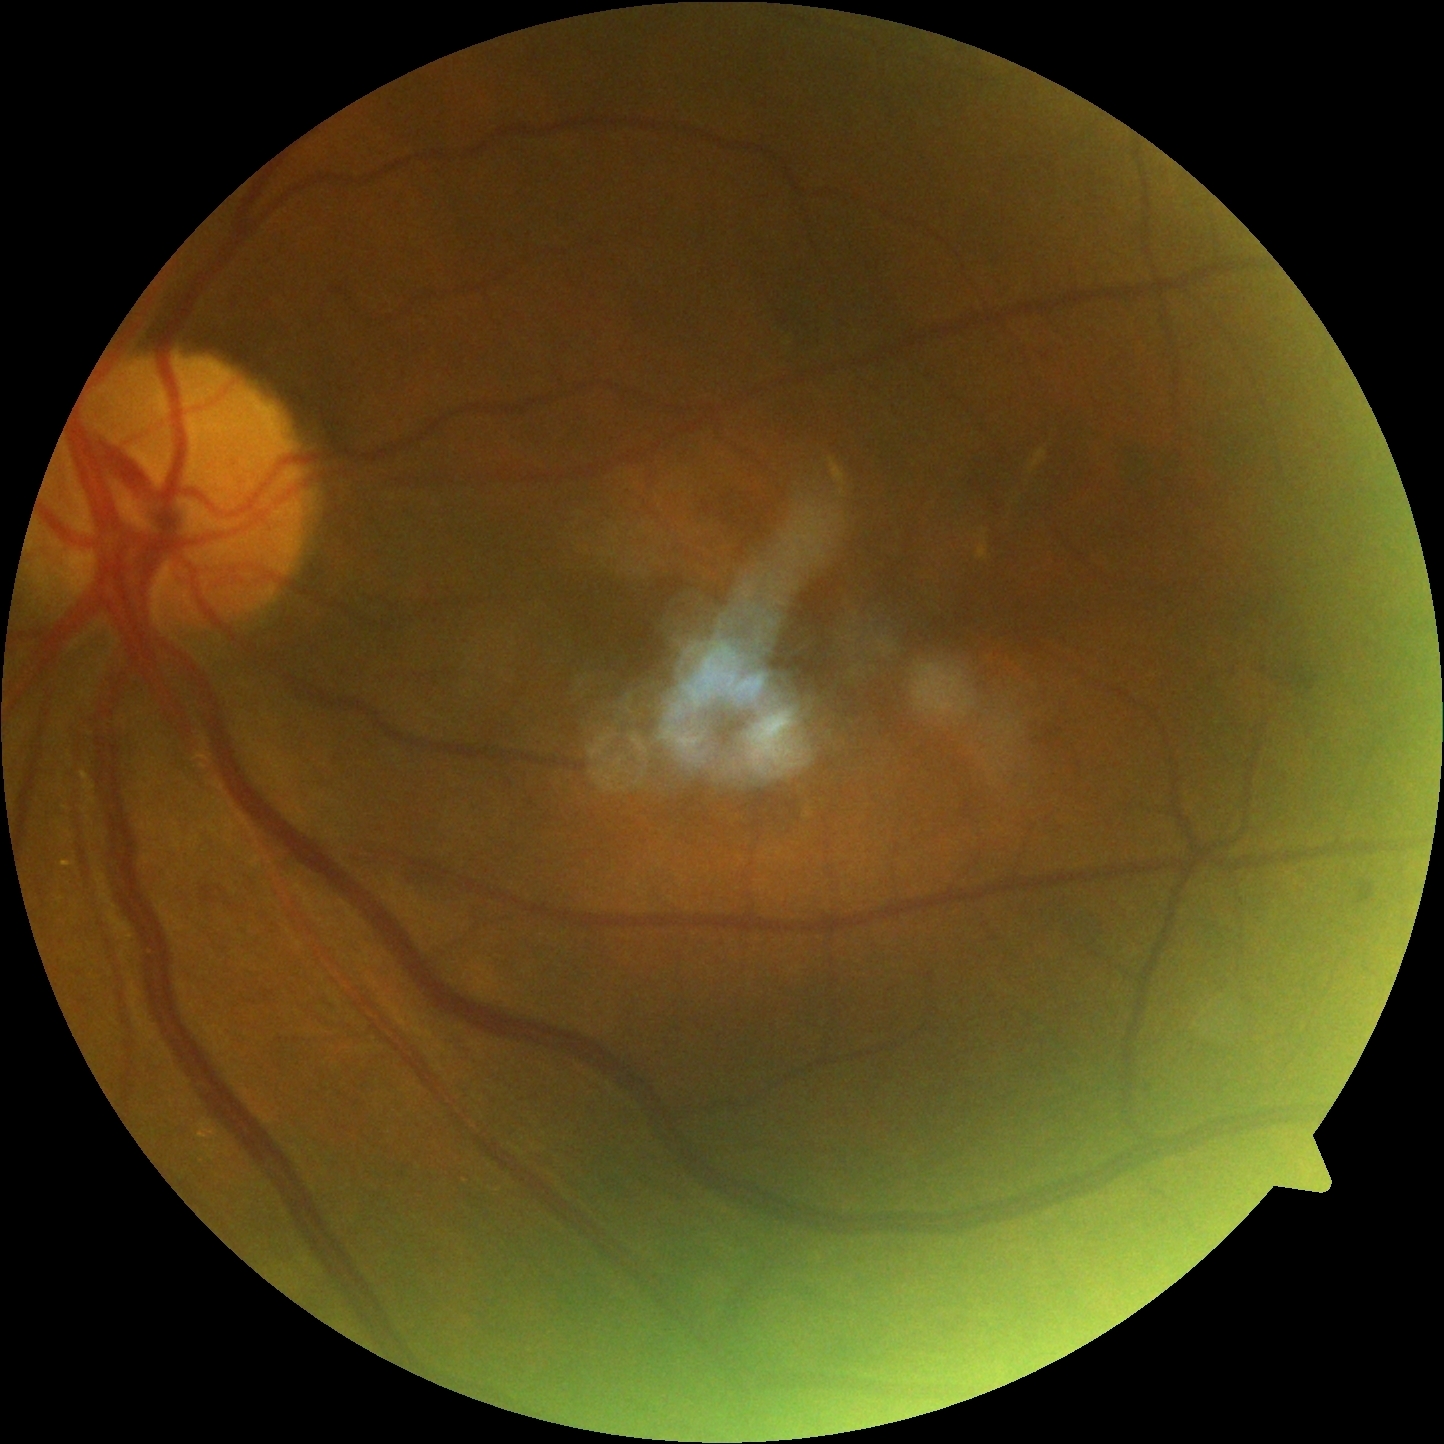

DR: grade 2 (moderate NPDR).